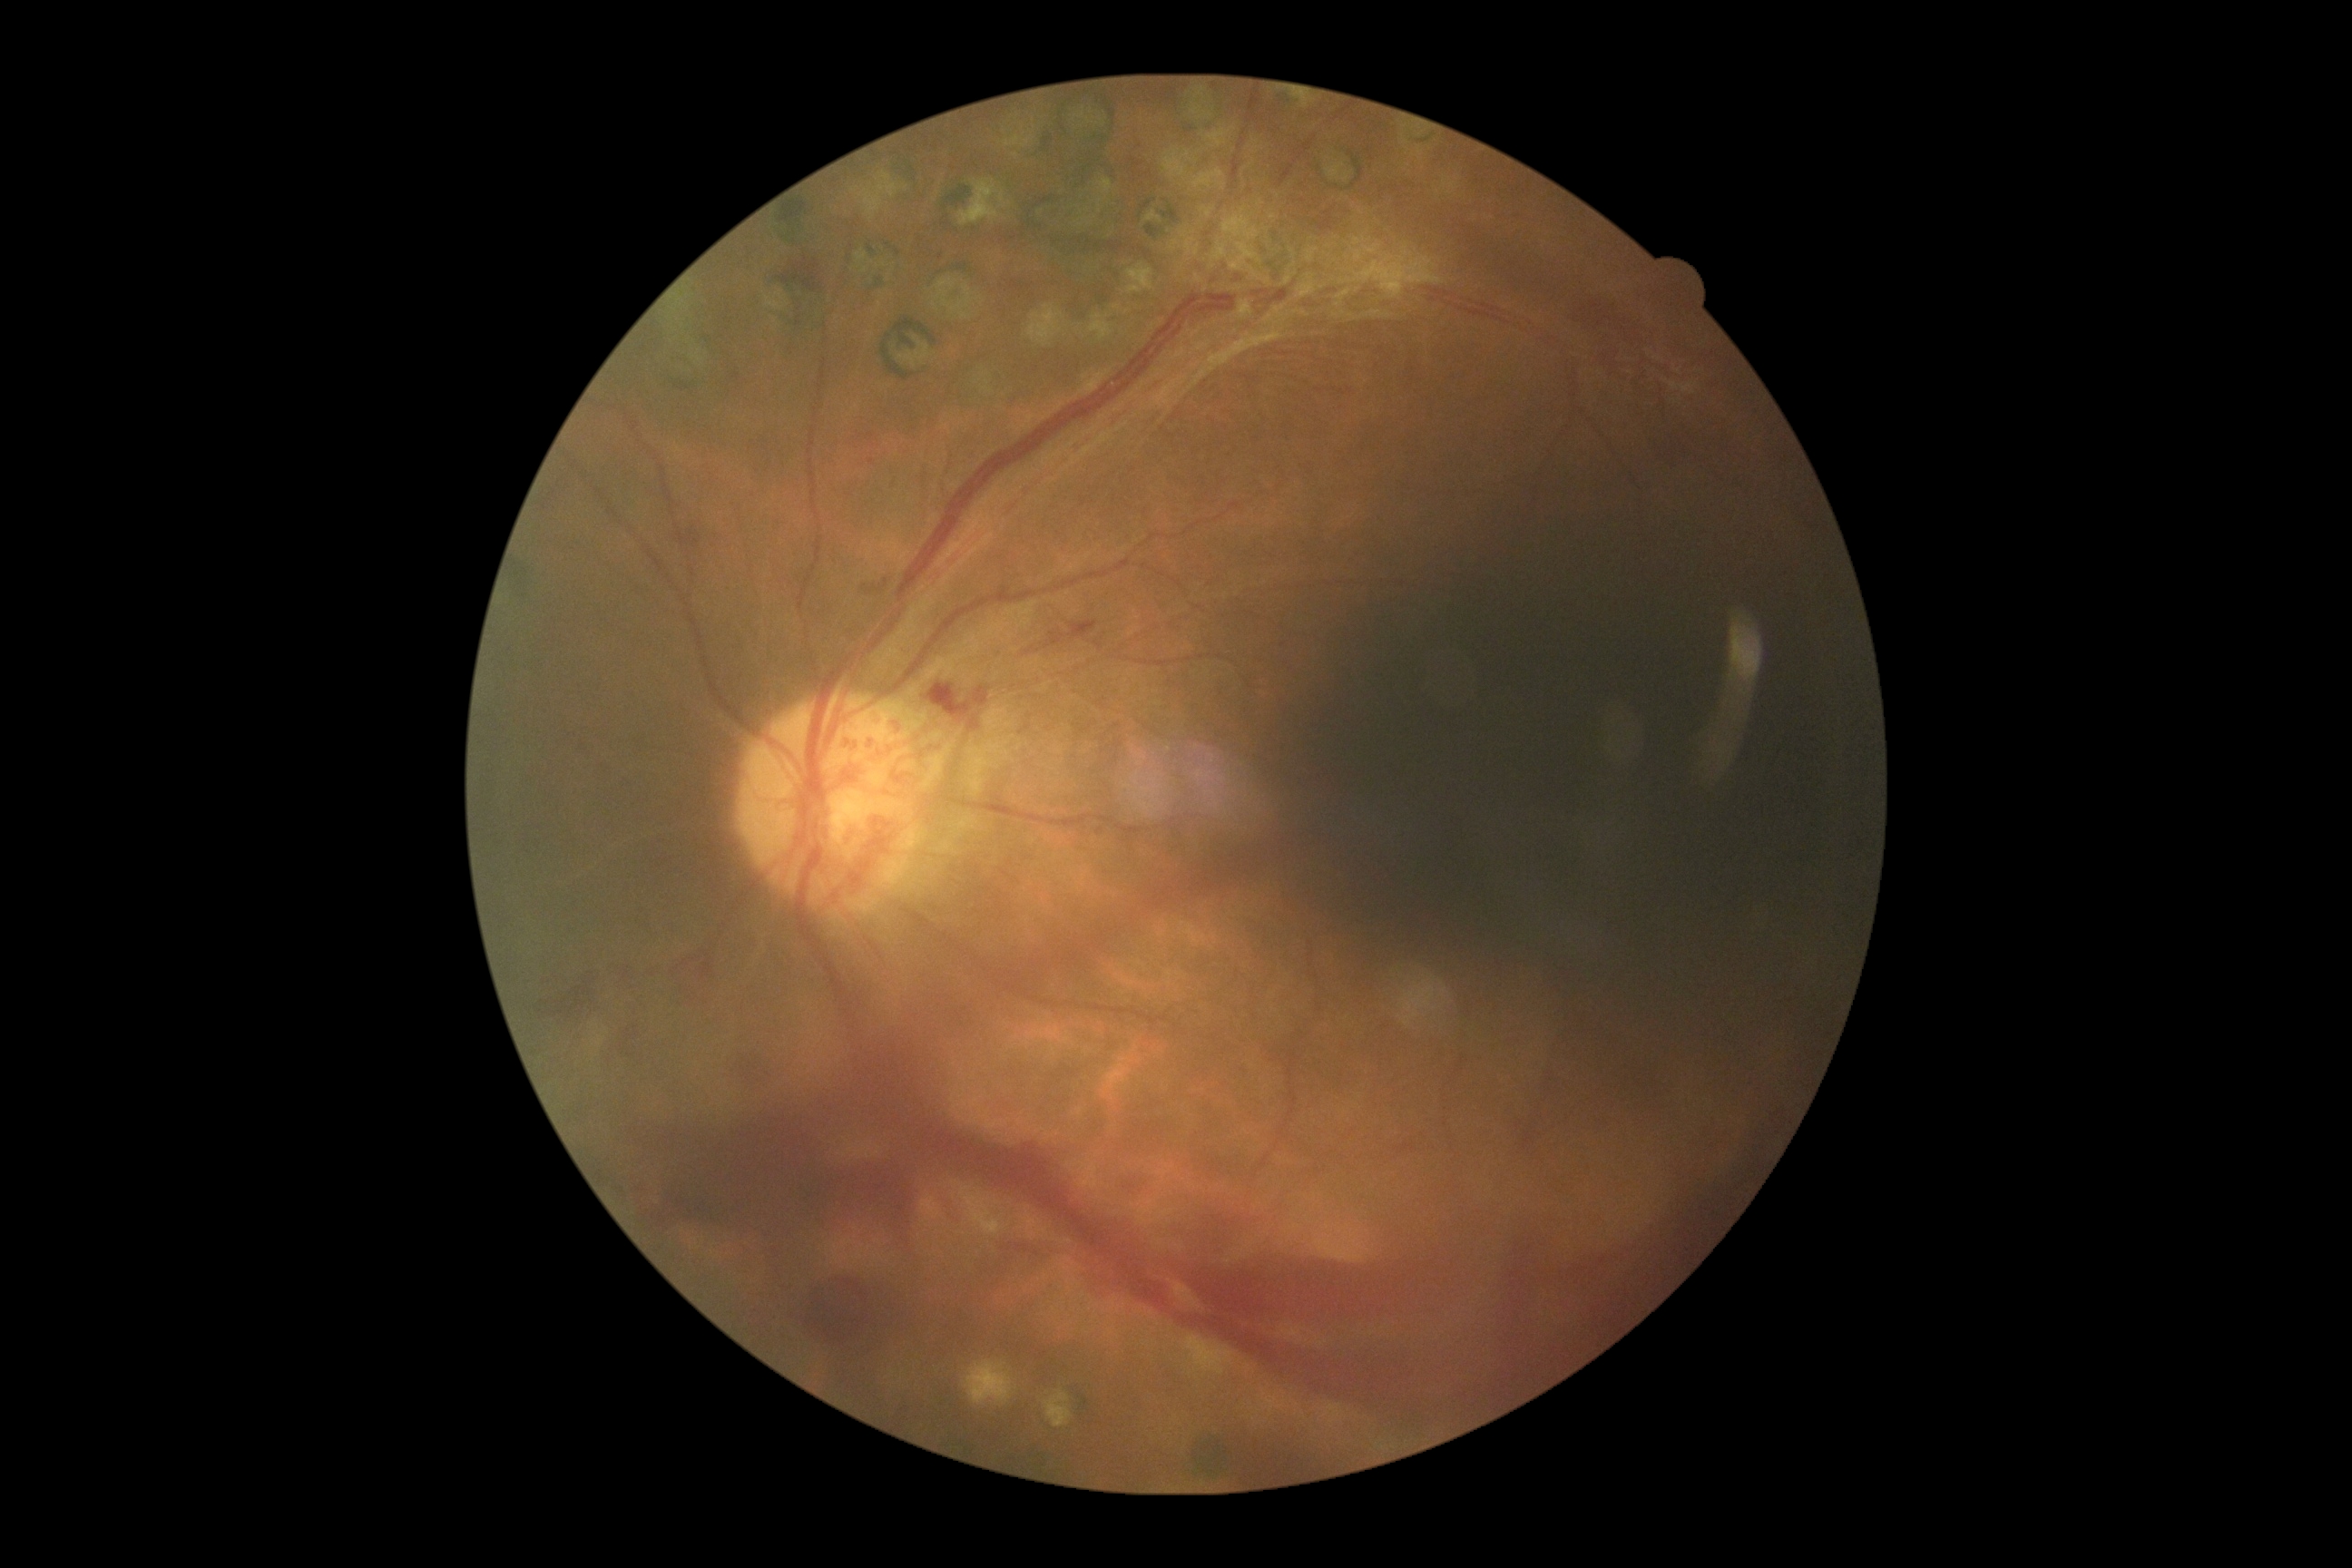

DR stage=grade 4 (PDR); DR class=proliferative diabetic retinopathy.